Pediatric retinal photograph (wide-field):
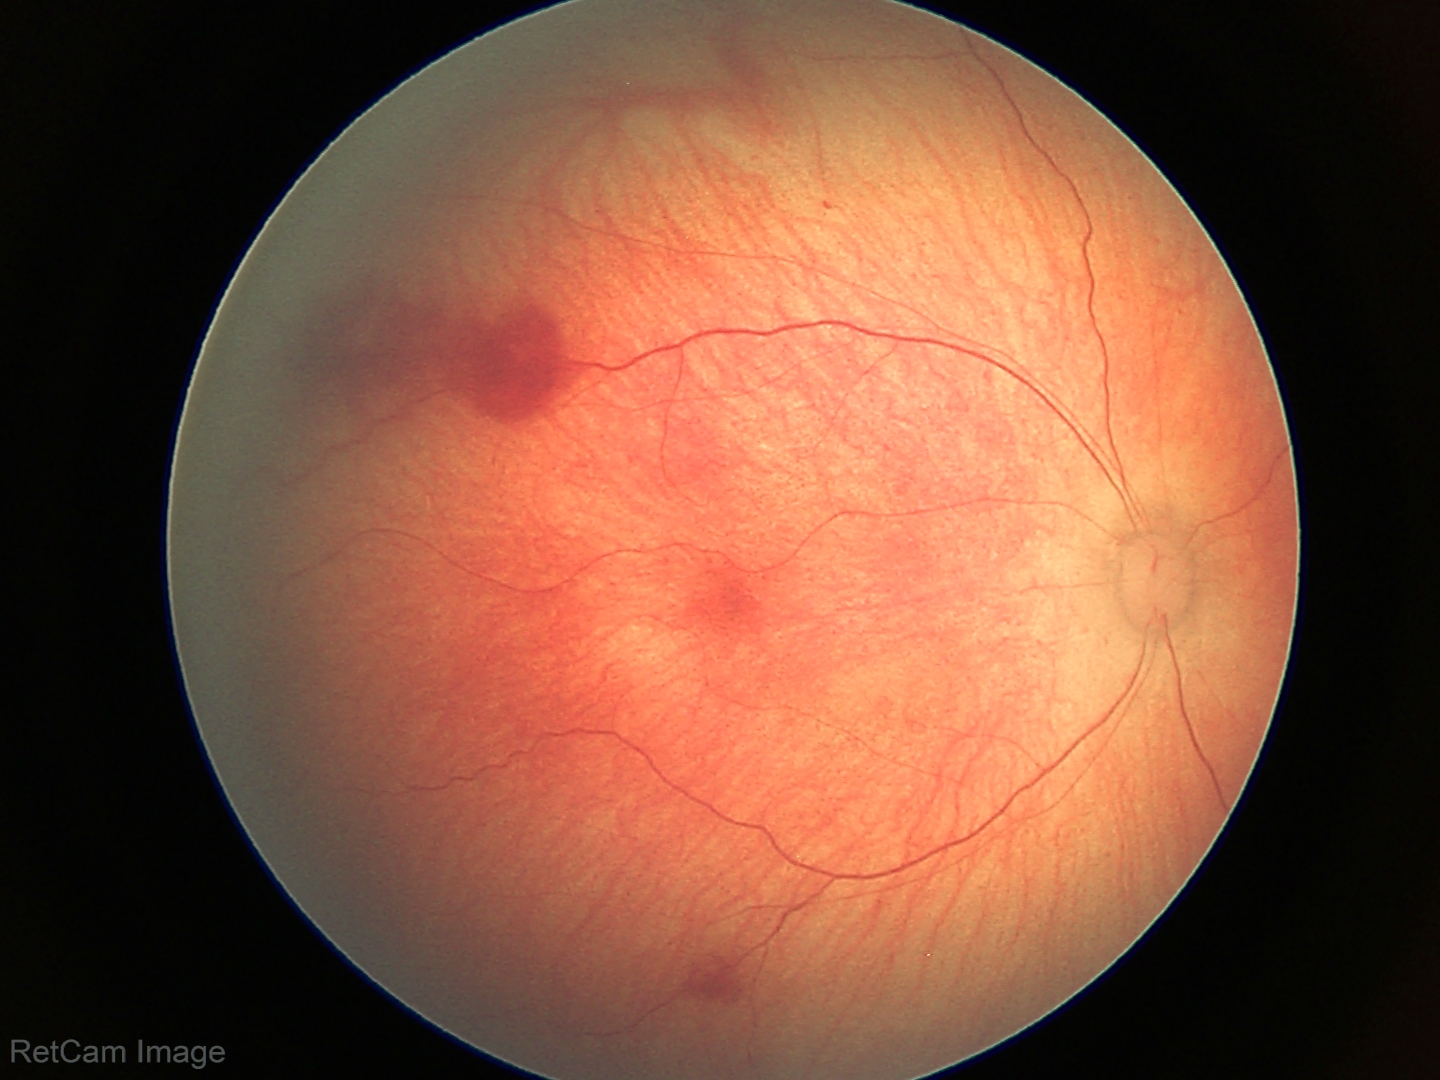
Diagnosis: retinal hemorrhages.